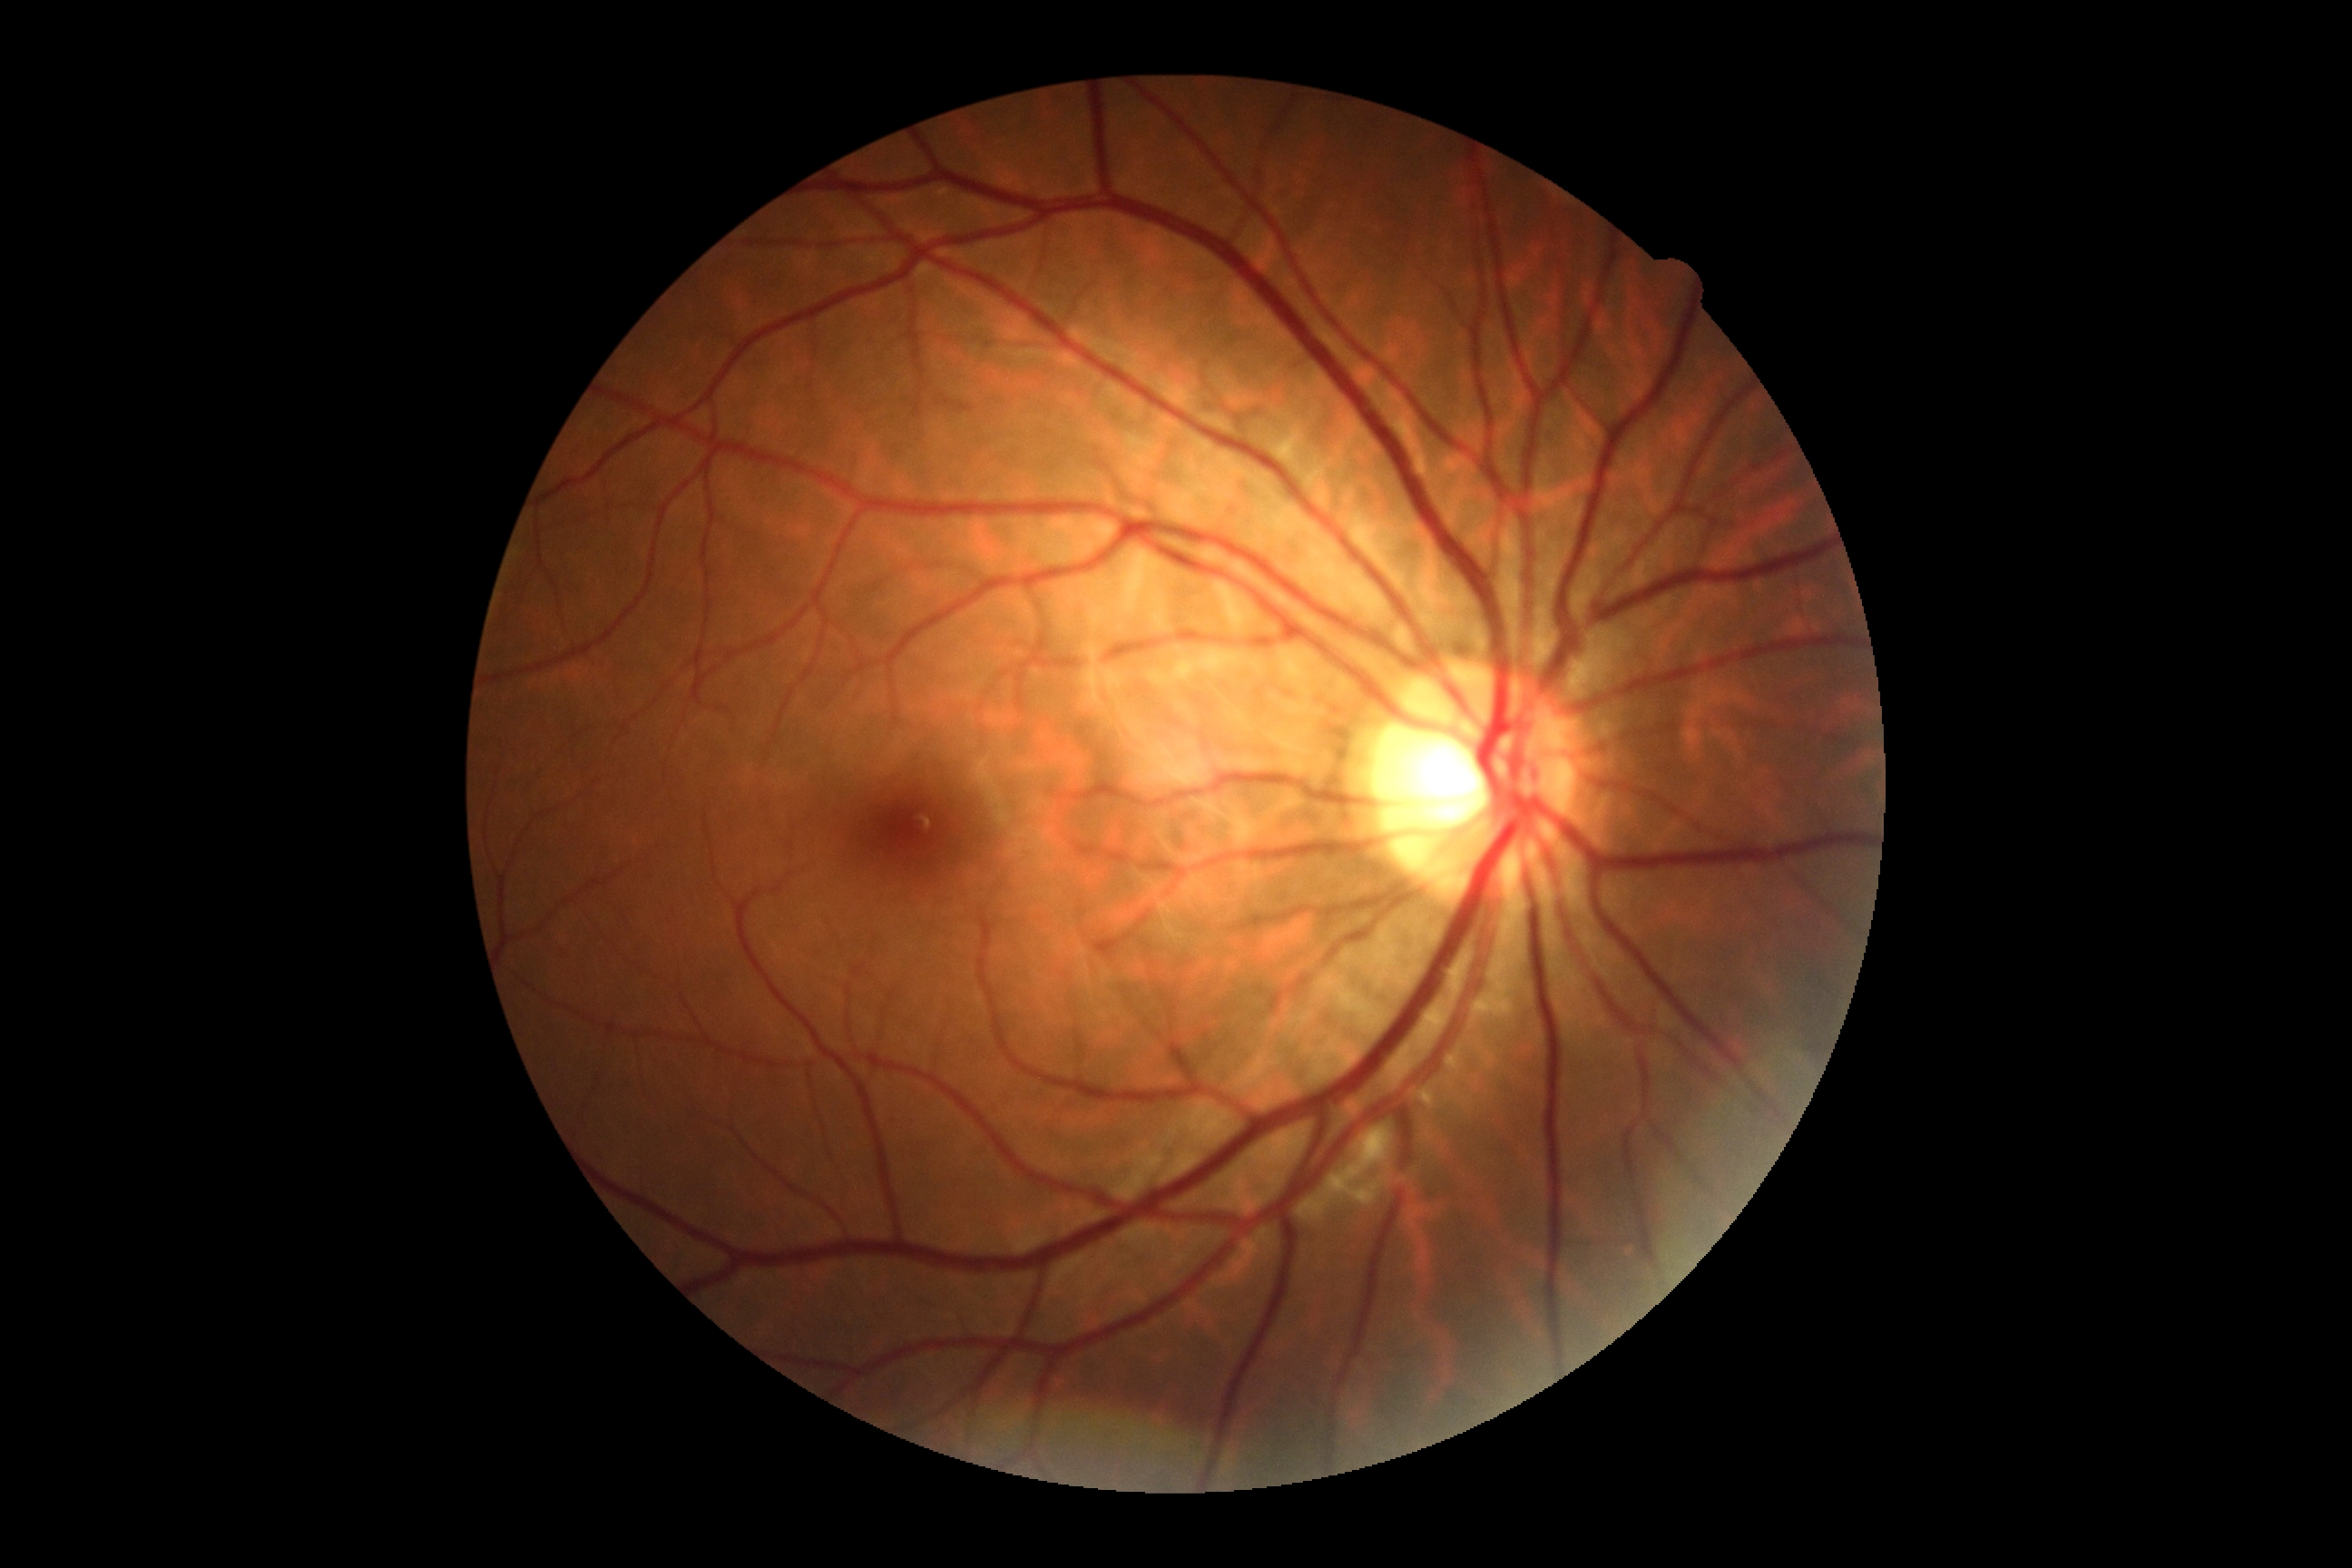
Retinopathy: 0/4.